2212x1659px. Color fundus photograph. 45-degree field of view:
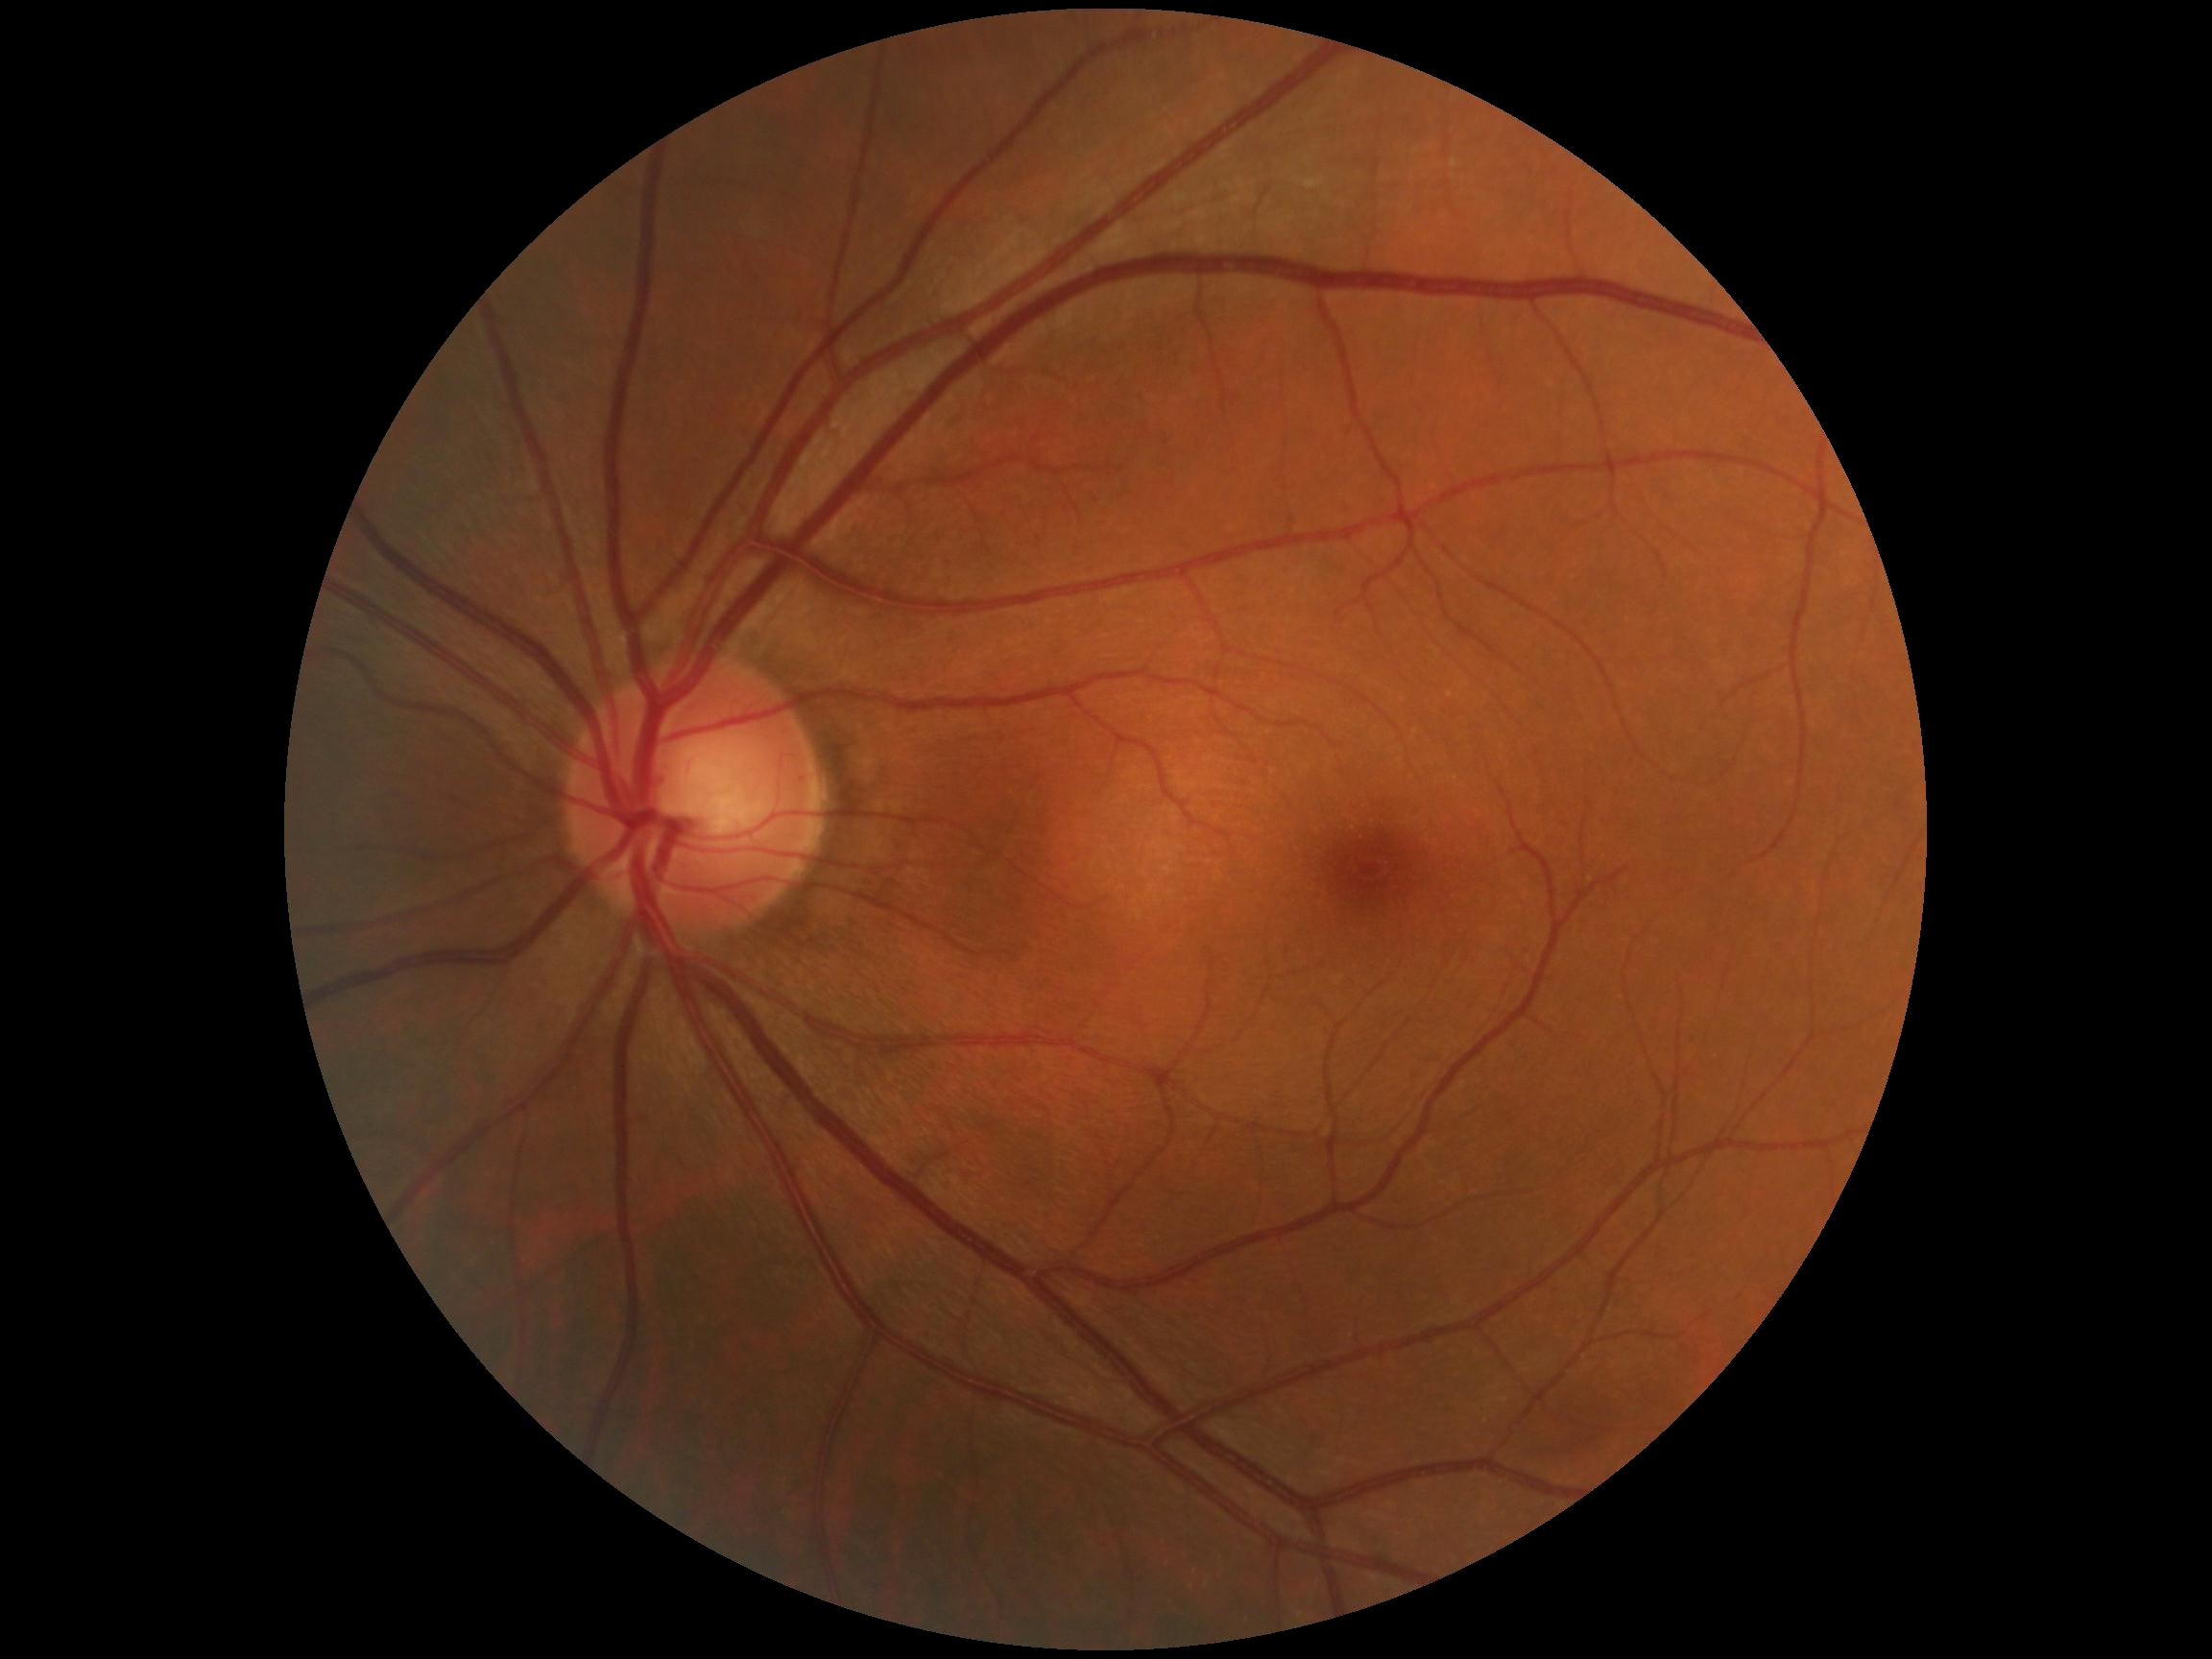

diabetic retinopathy (DR) = grade 0 (no apparent retinopathy) | DR impression = negative for DR.